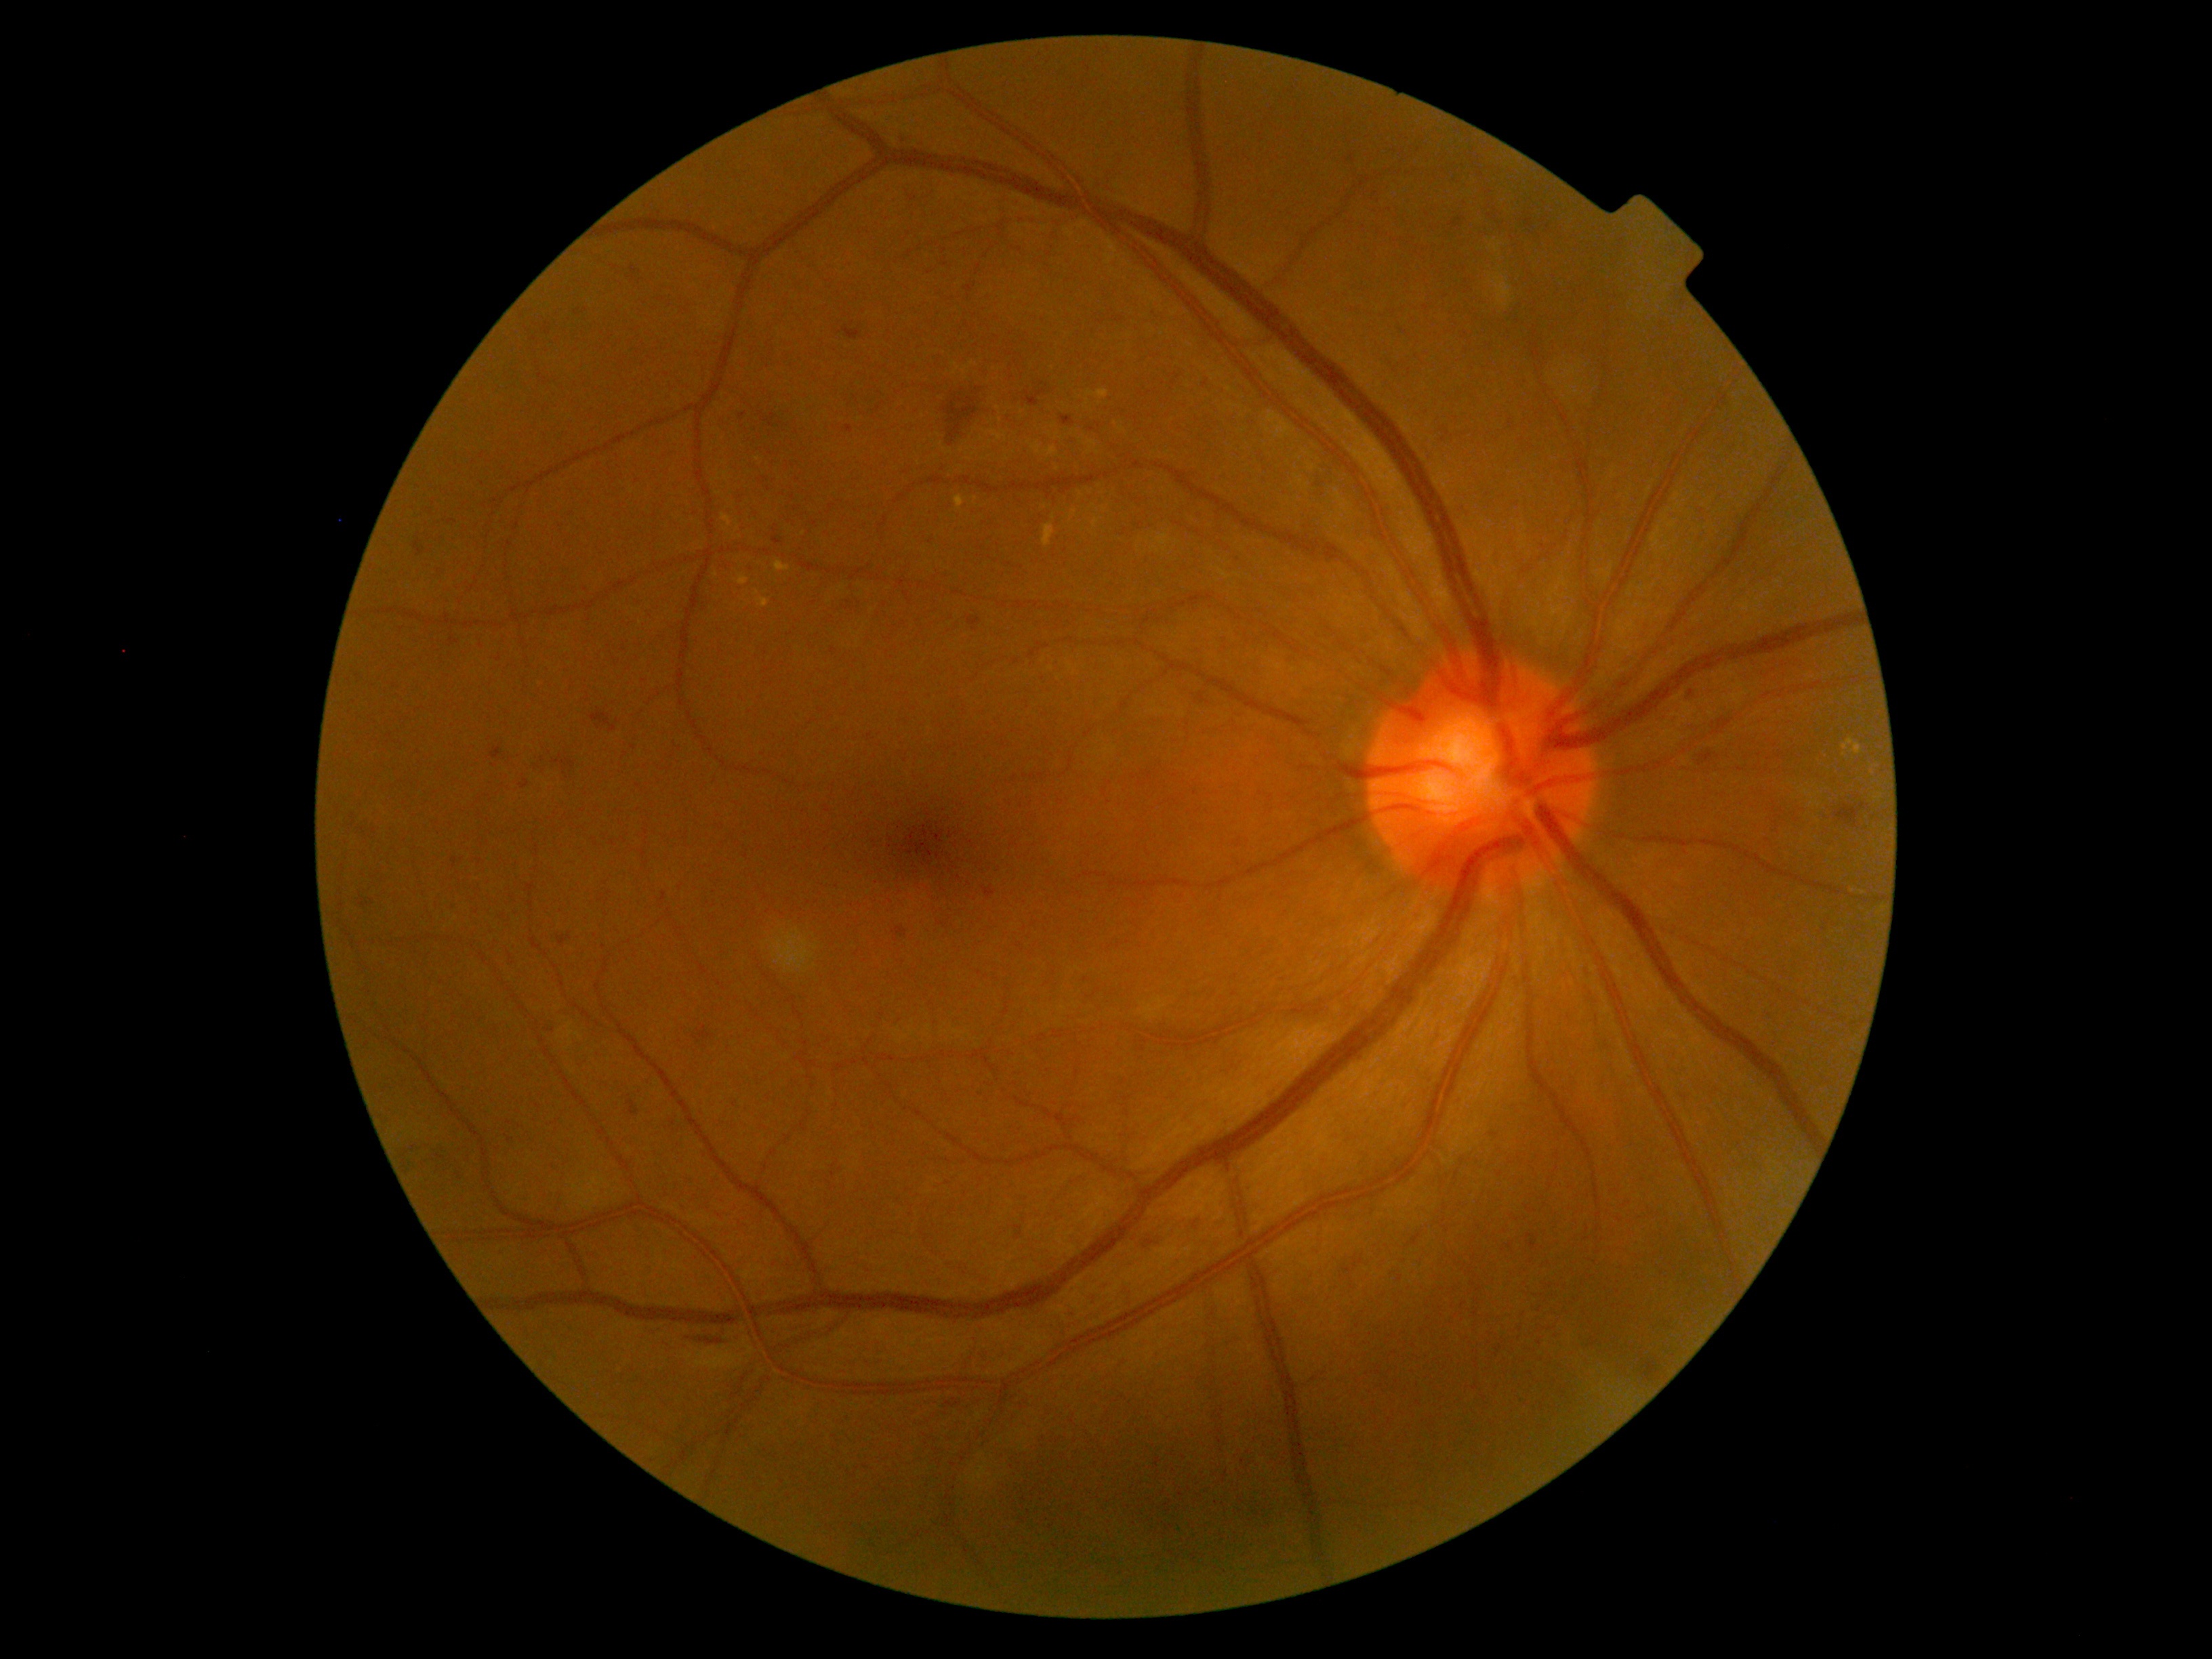 Diabetic retinopathy (DR) is 2; non-proliferative diabetic retinopathy
Representative lesions:
hard exudates (EXs) (partial) = 954 495 966 510 | 1093 518 1100 528 | 756 597 771 608 | 722 514 731 527 | 1843 738 1863 756 | 1088 390 1109 399 | 775 560 790 573 | 1032 443 1040 455 | 1046 448 1059 456 | 1043 524 1055 547 | 738 574 750 585
Small EXs near (x=975, y=499) | (x=726, y=474) | (x=757, y=594) | (x=1073, y=513)
soft exudates (SEs) = none identified
hemorrhages (HEs) (partial) = 894 131 920 146 | 544 323 552 334 | 490 747 501 760 | 563 760 575 768 | 941 394 978 448 | 893 926 907 943 | 1527 1235 1538 1250 | 628 1100 639 1116 | 357 821 377 842 | 1699 750 1713 765 | 661 893 666 902 | 739 413 747 418 | 631 266 636 280
Small HEs near (x=870, y=736) | (x=415, y=1147) | (x=735, y=1105) | (x=1511, y=1246) | (x=1150, y=1243)
microaneurysms (MAs) = none identified